Color fundus photograph from a handheld portable camera:
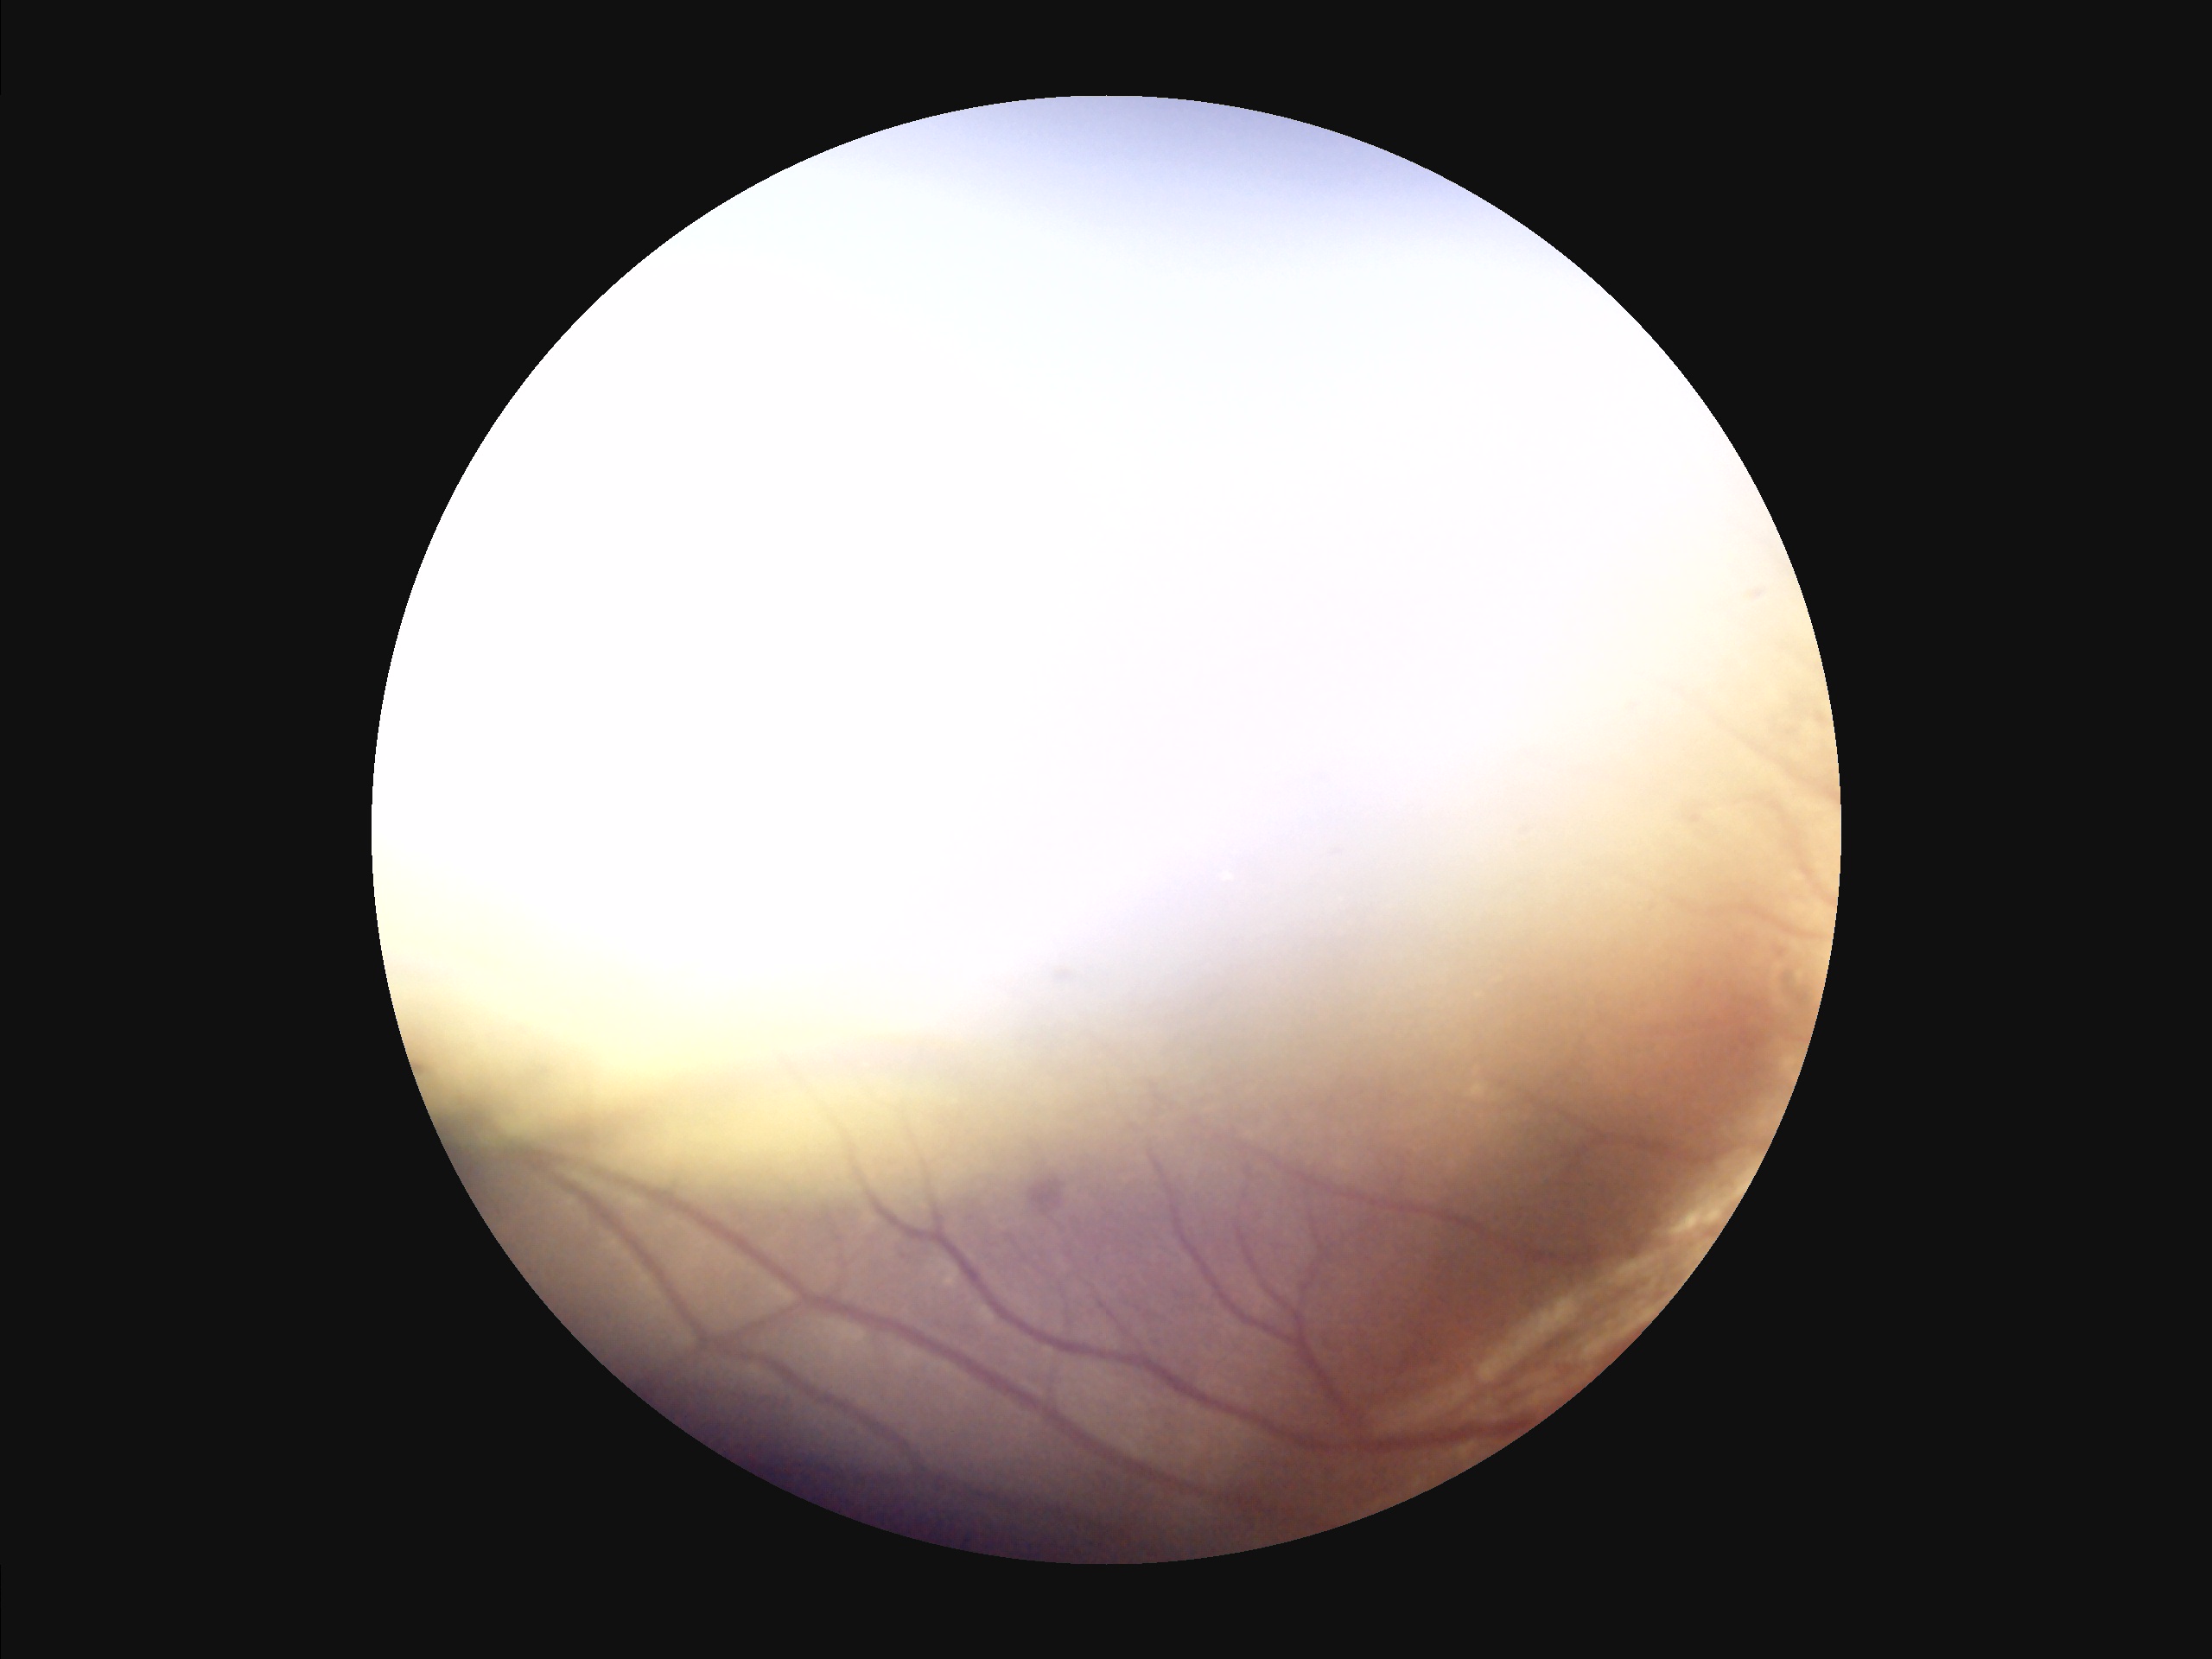
Illumination is uneven. Image quality is suboptimal. Reduced sharpness with visible blur. Vessels and details are hard to distinguish.